Without pupil dilation; 848x848; CFP.
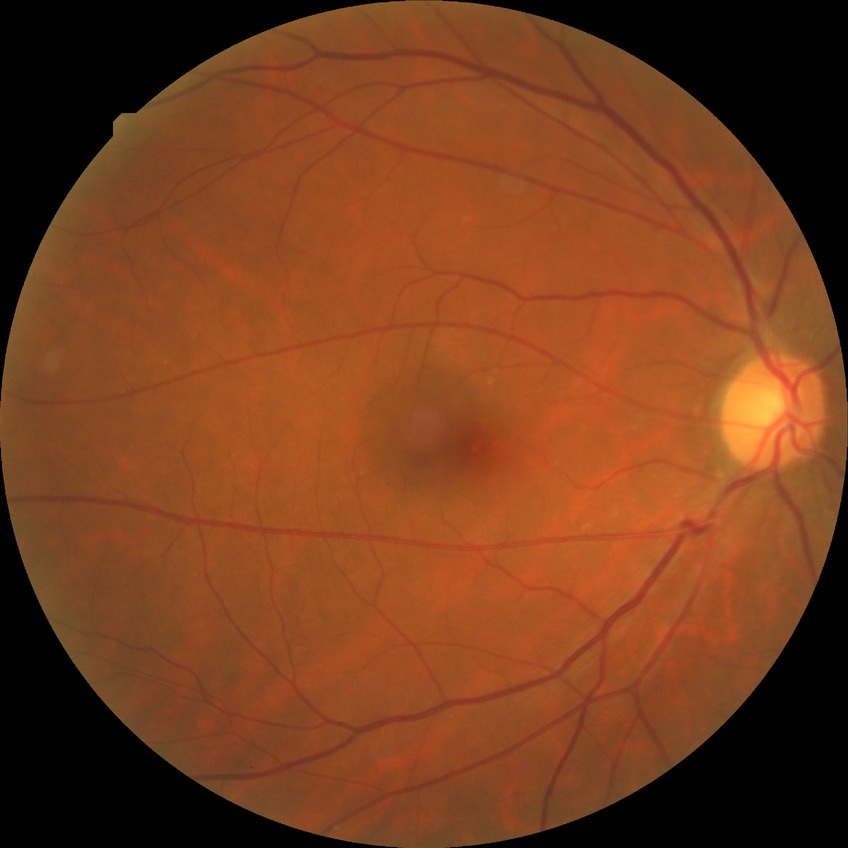

DR impression@no apparent DR; DR severity@NDR.